848 x 848 pixels, 45° field of view
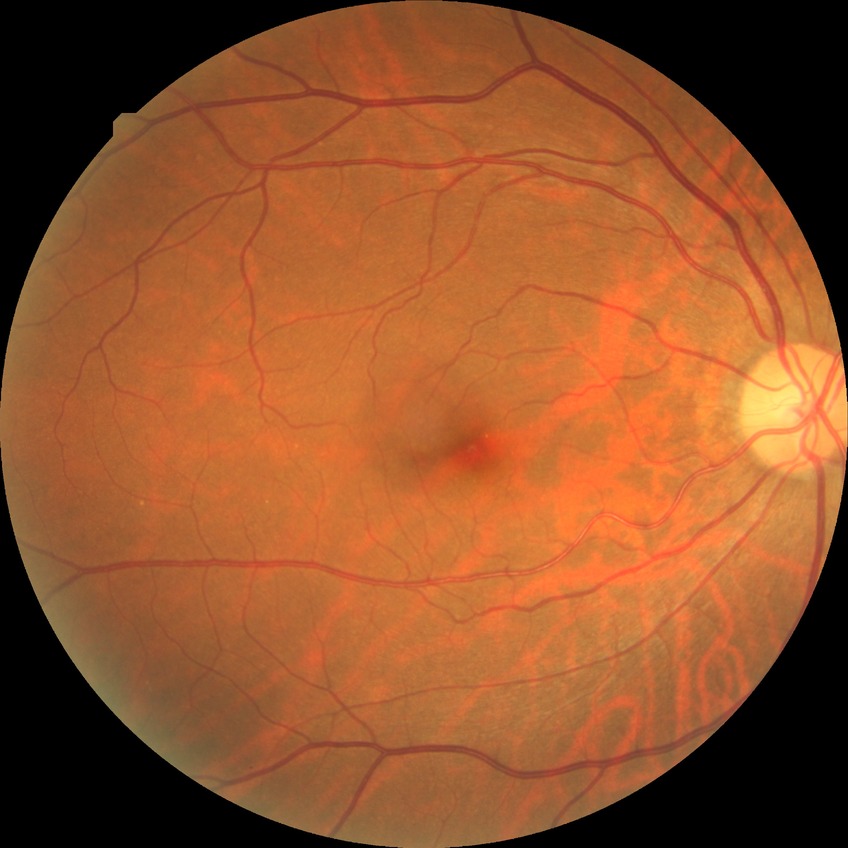 {
  "davis_grade": "no diabetic retinopathy"
}